45-degree field of view, color fundus photograph: 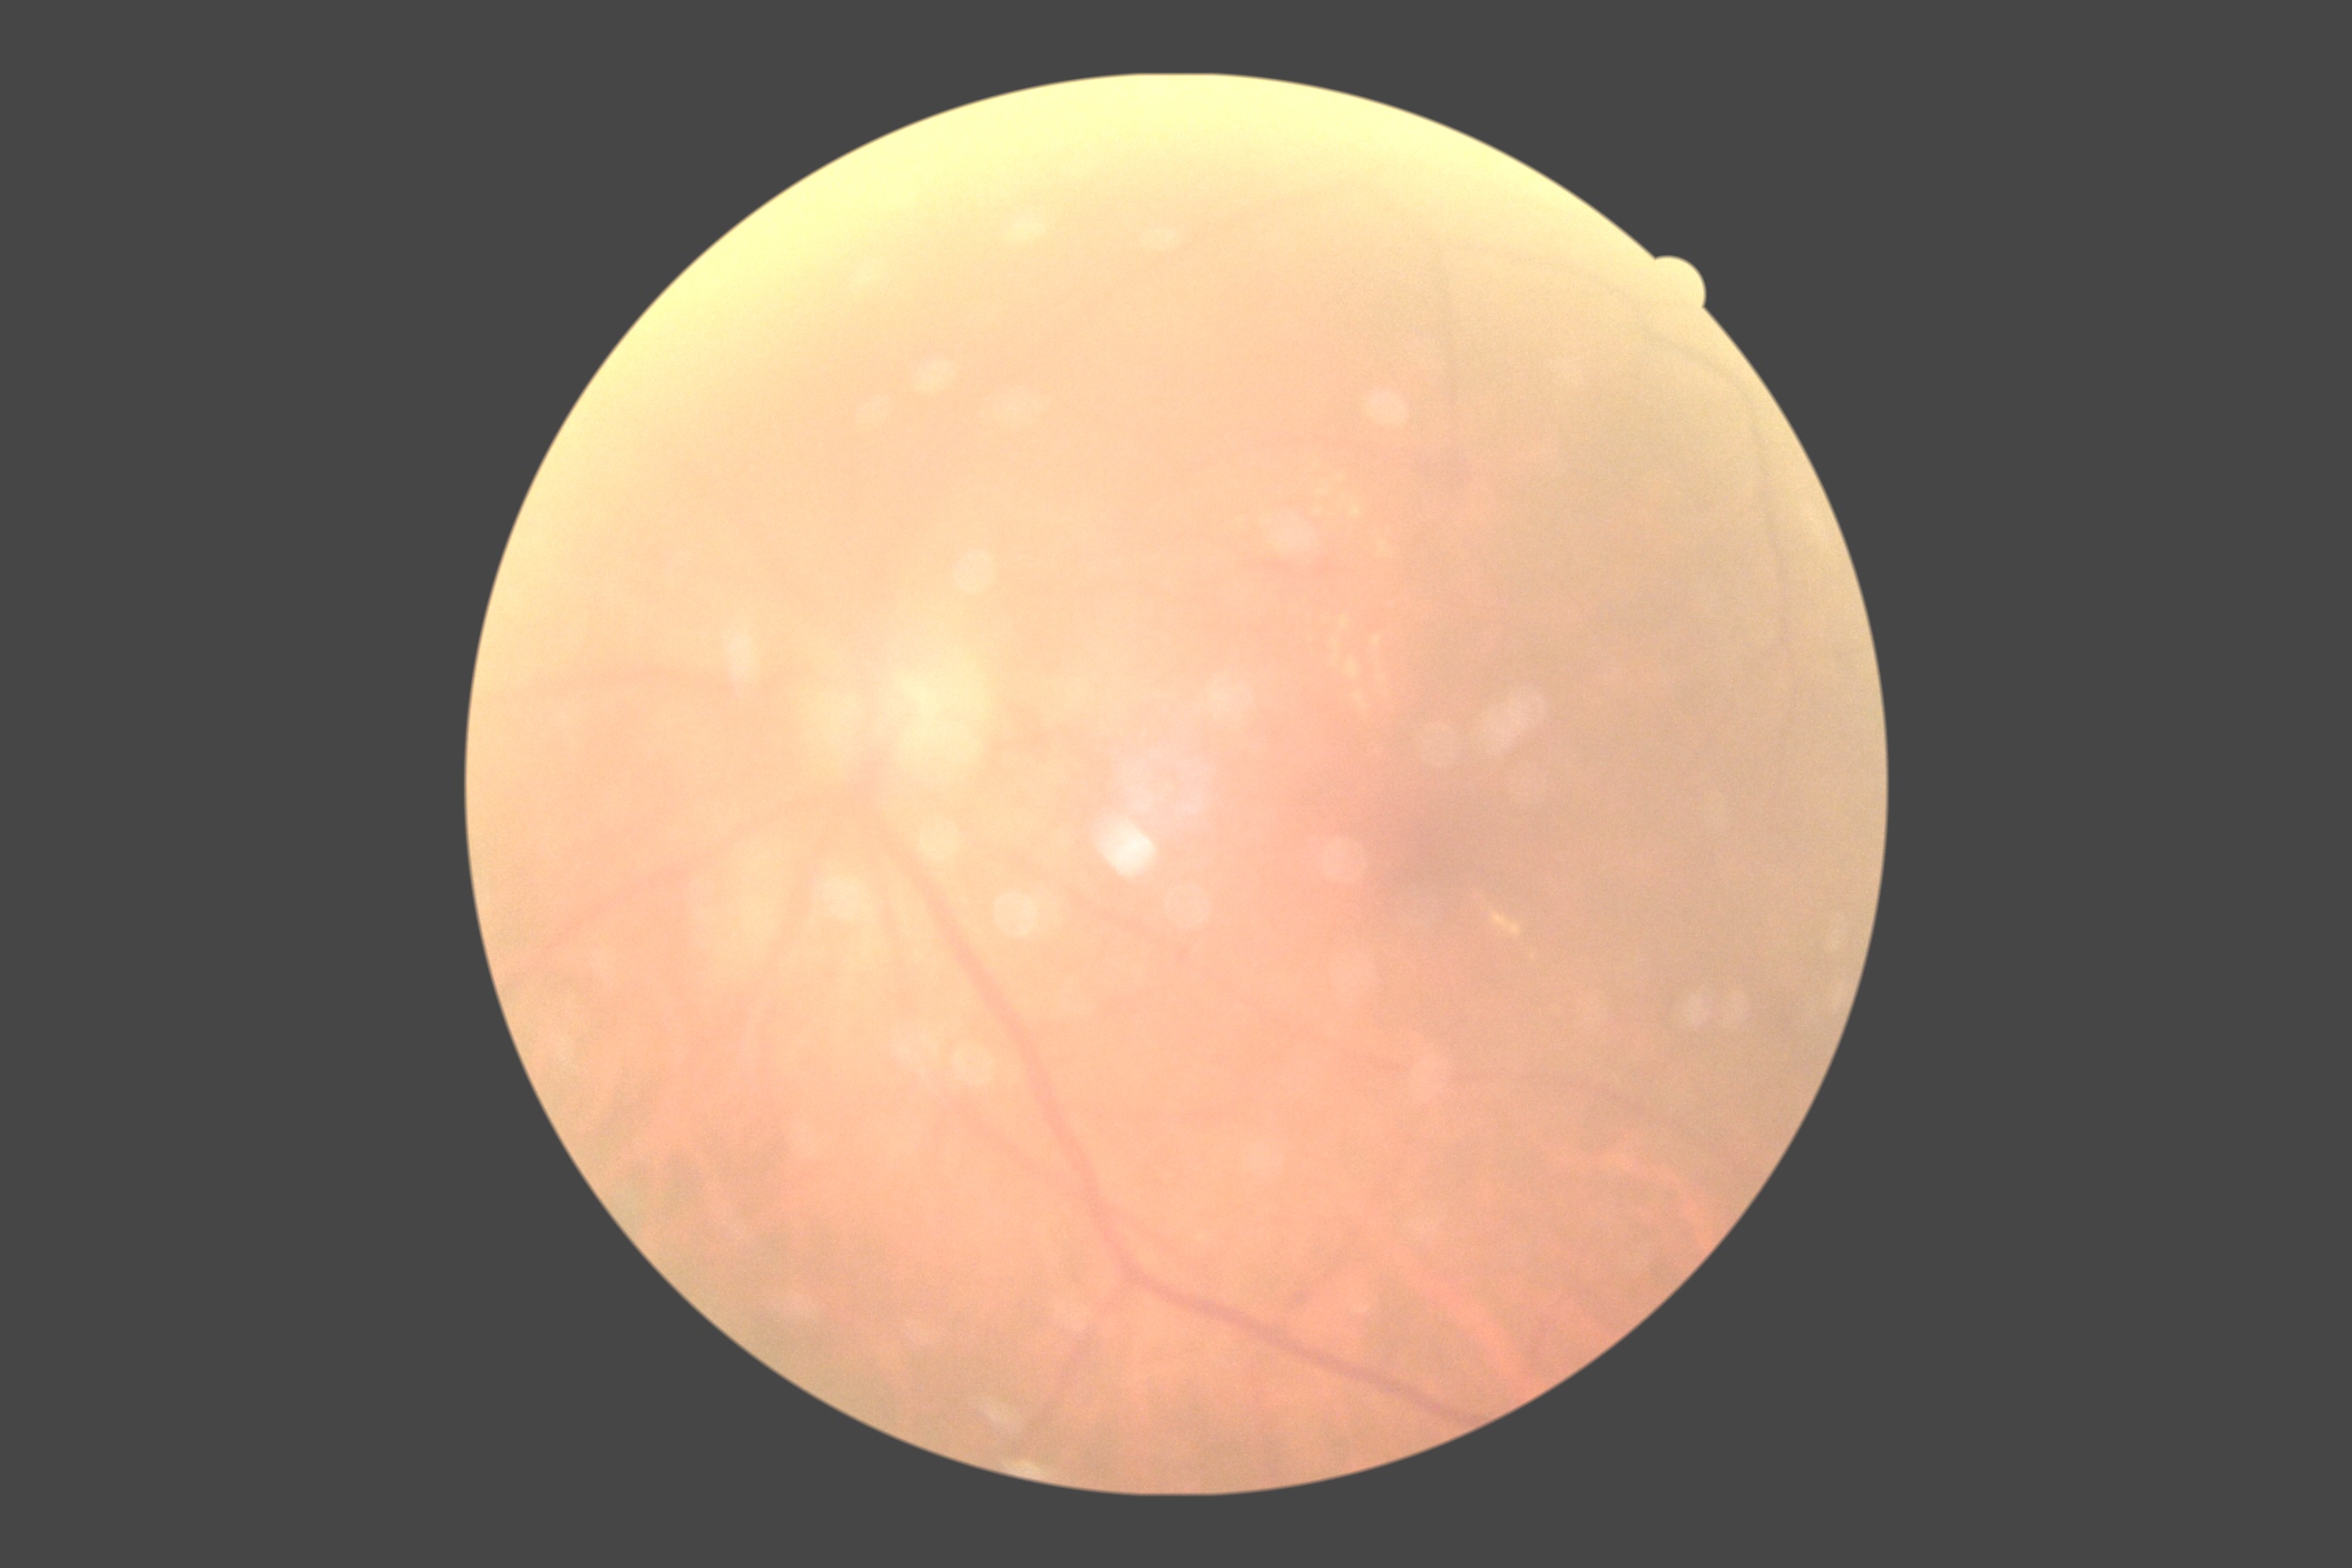

Diabetic retinopathy (DR) is grade 2.